240x240px. Non-mydriatic acquisition. Nidek AFC-330: 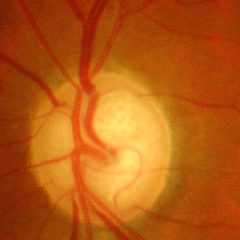
Severe glaucomatous damage.